Wide-field contact fundus photograph of an infant — 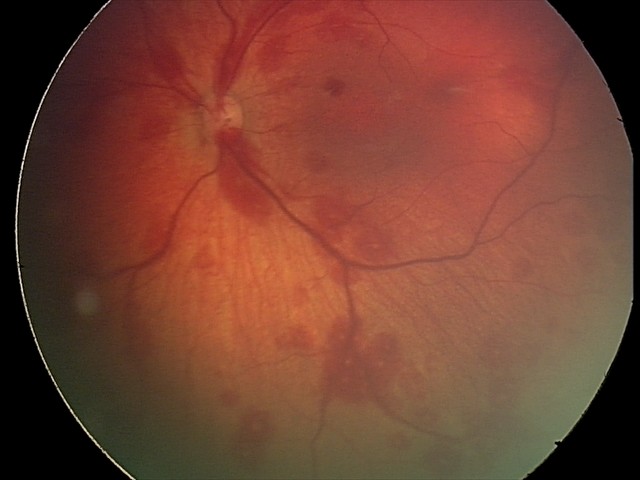
Diagnosis = retinal hemorrhages